Without pupil dilation, acquired with a NIDEK AFC-230 — 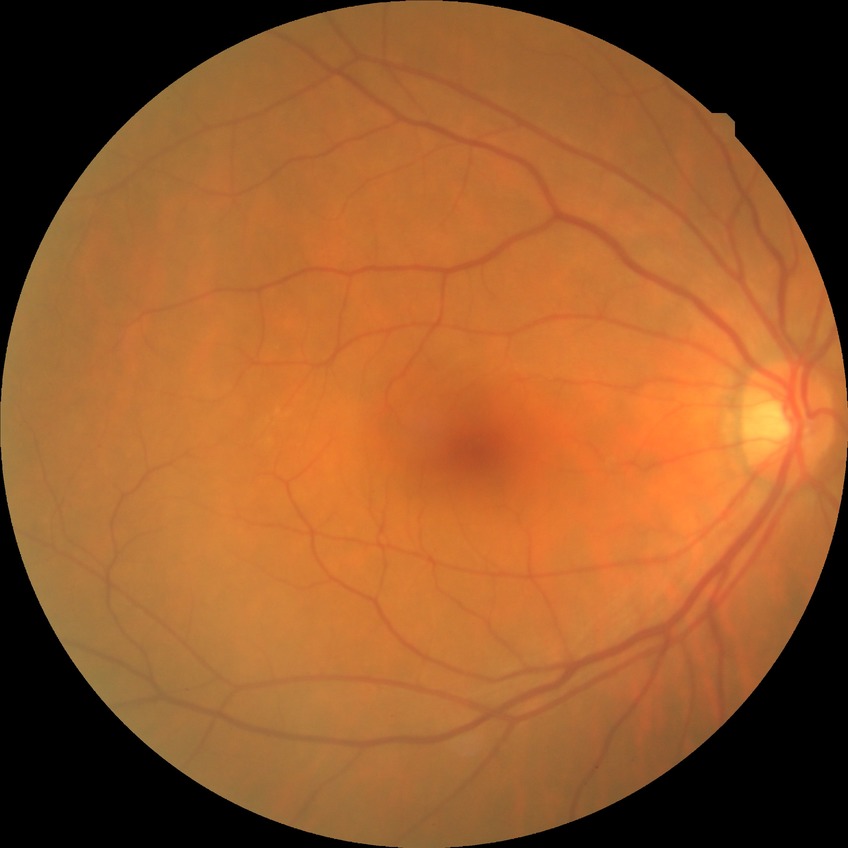
diabetic retinopathy (DR): no diabetic retinopathy (NDR).